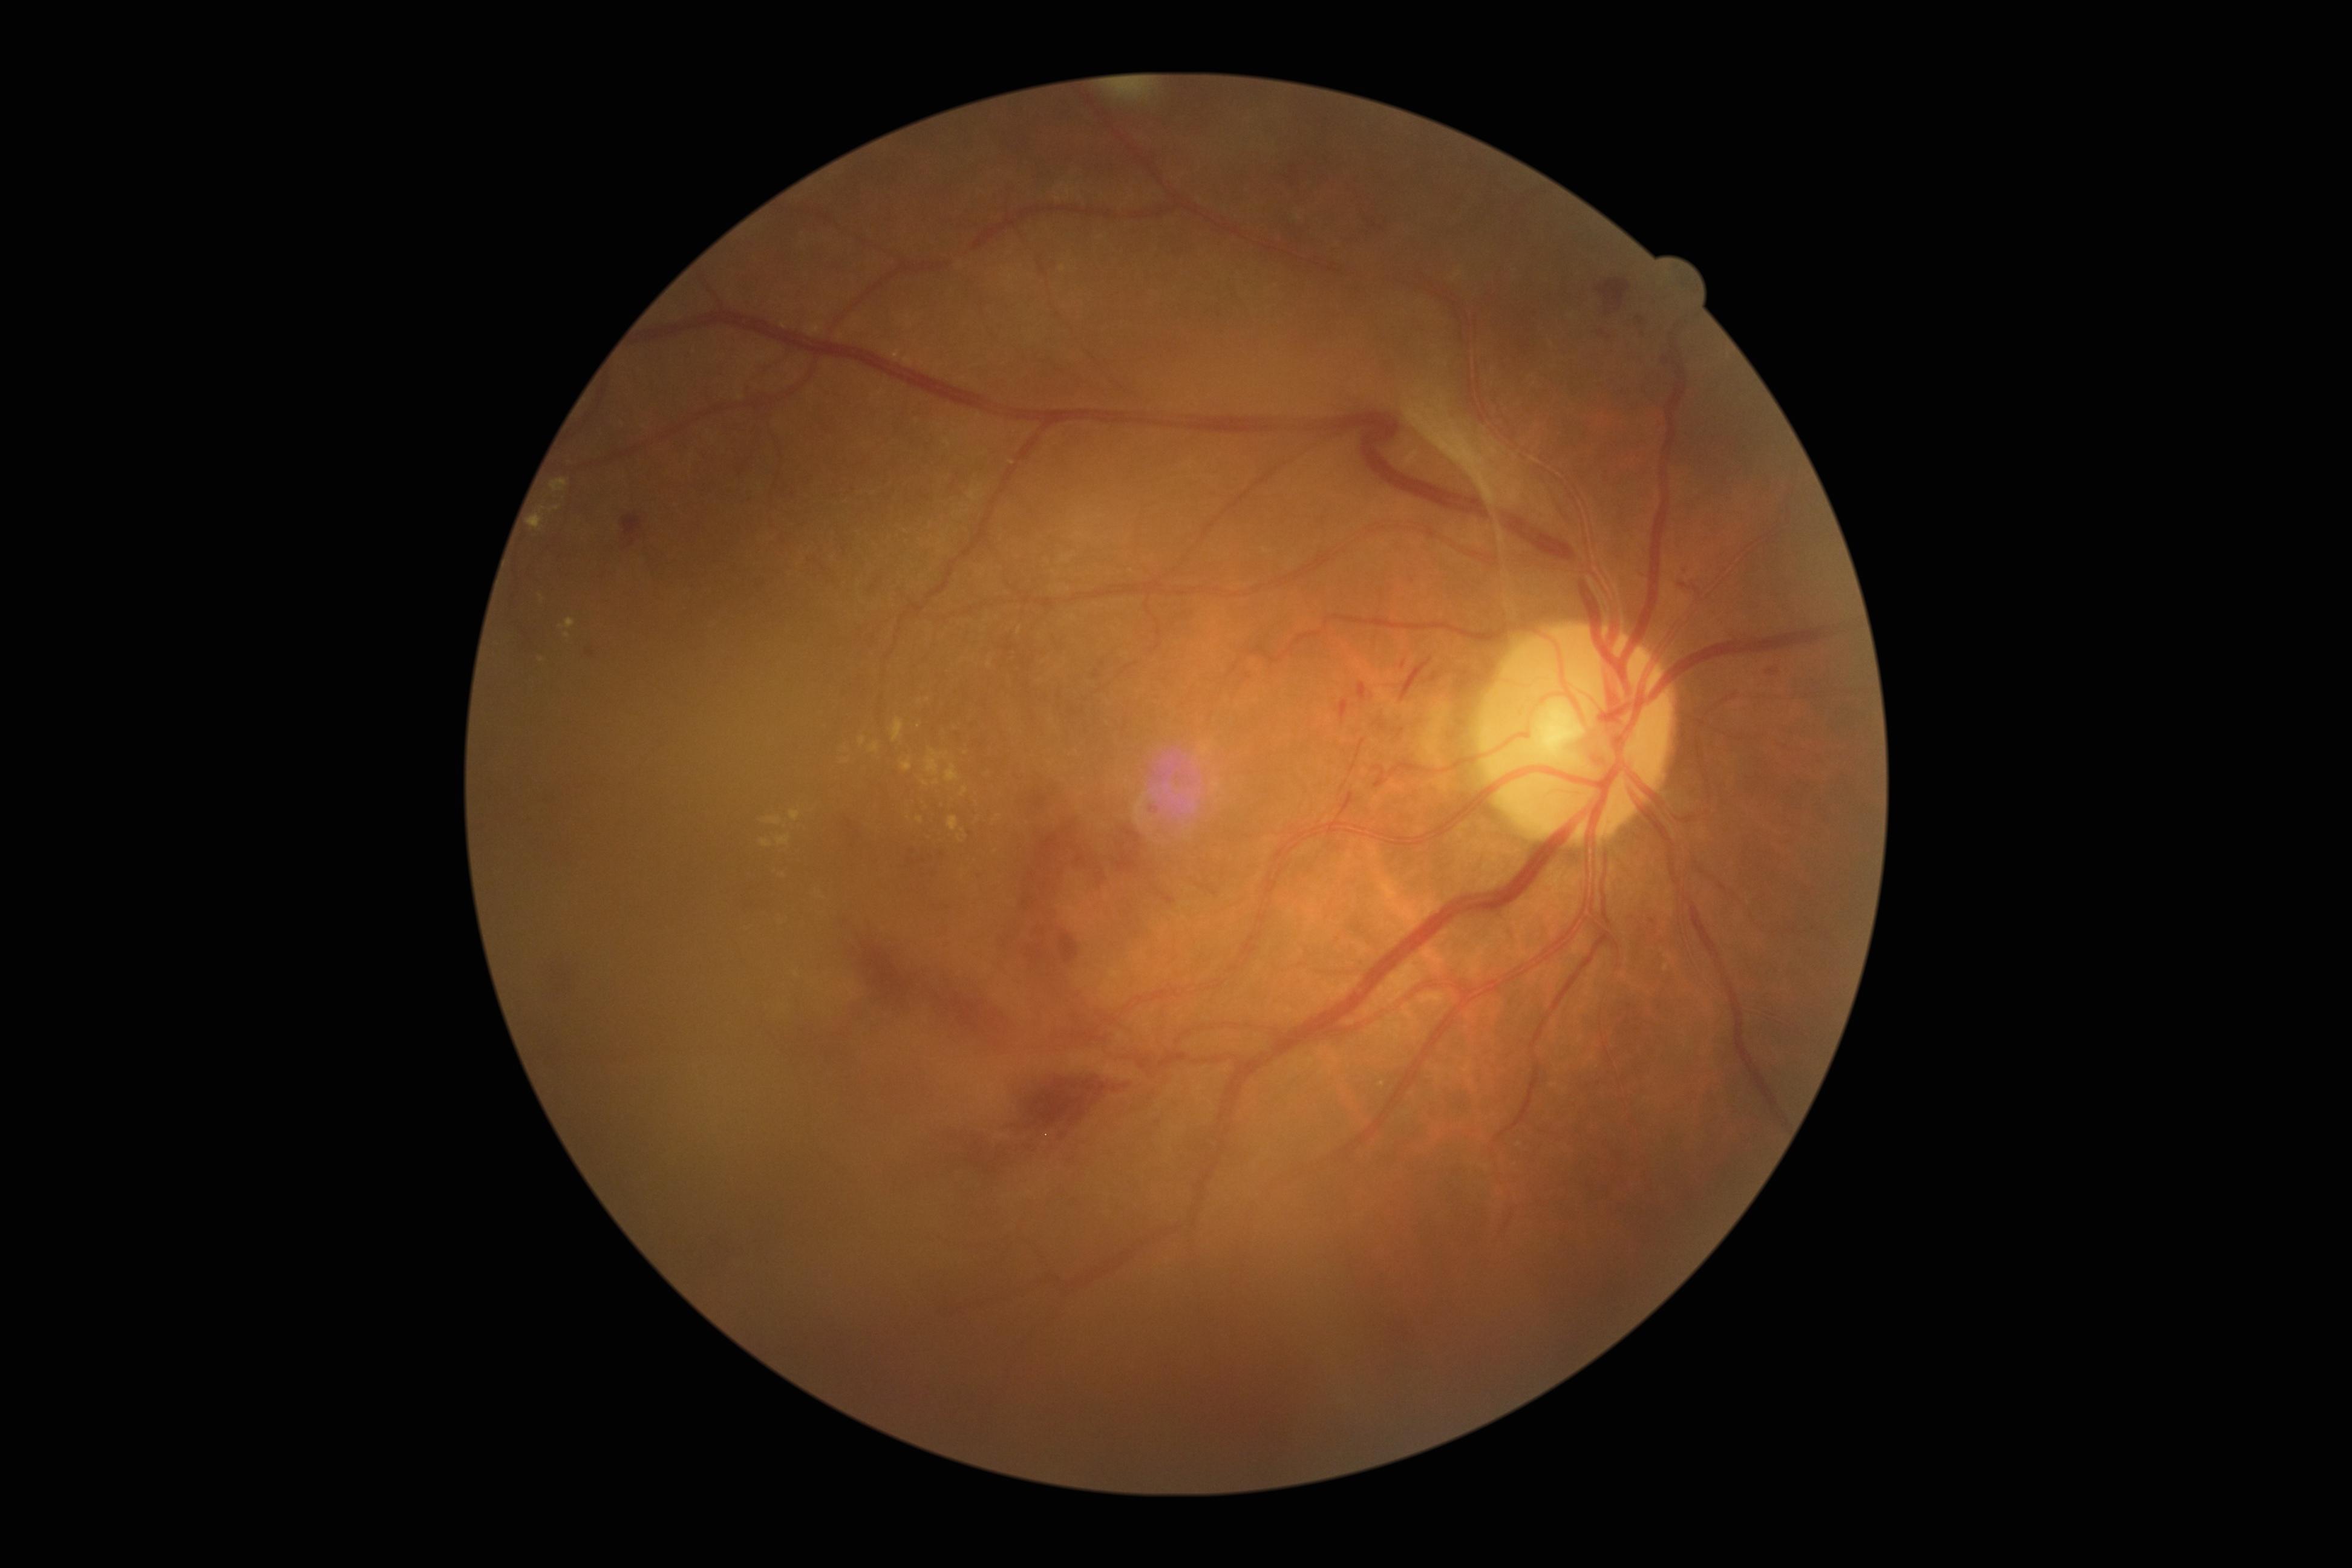 Annotations:
– DR stage — grade 4 (PDR)